Refractive error: -0.25 -0.5 × 70°; man patient; 43-year-old patient; axial length 26 mm.
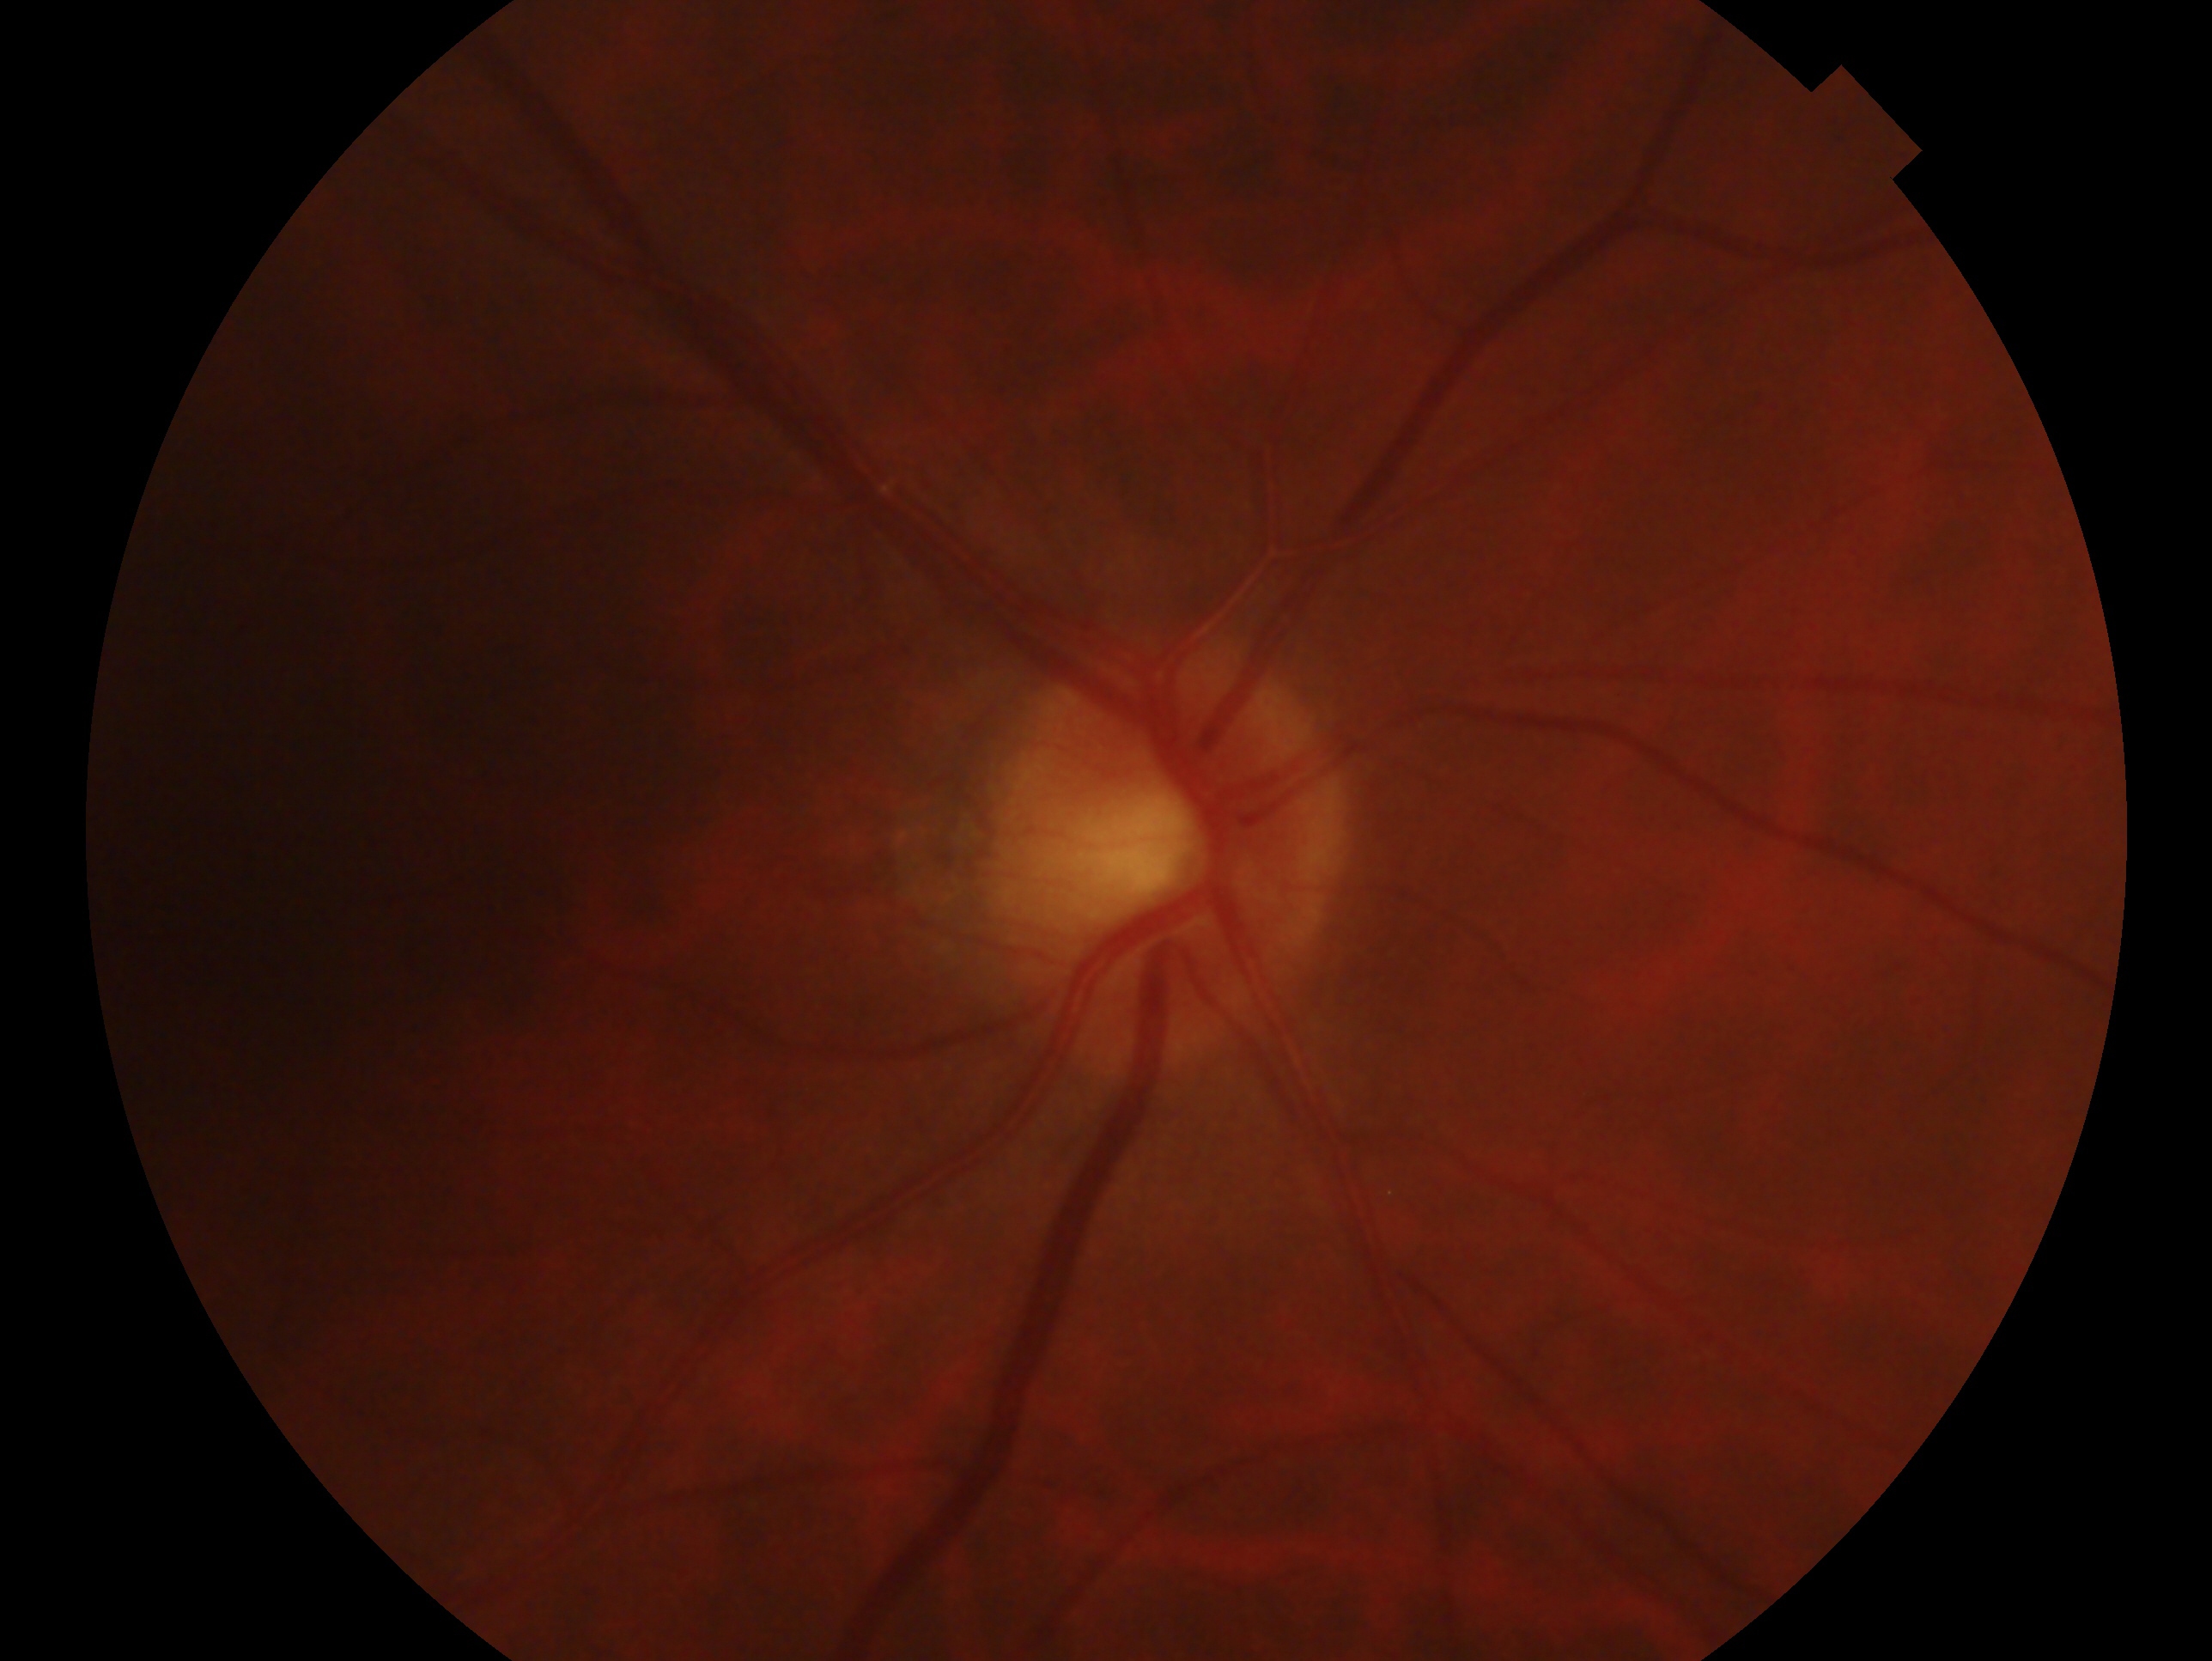

{"glaucoma_dx": "no evidence of glaucoma", "eye": "right"}